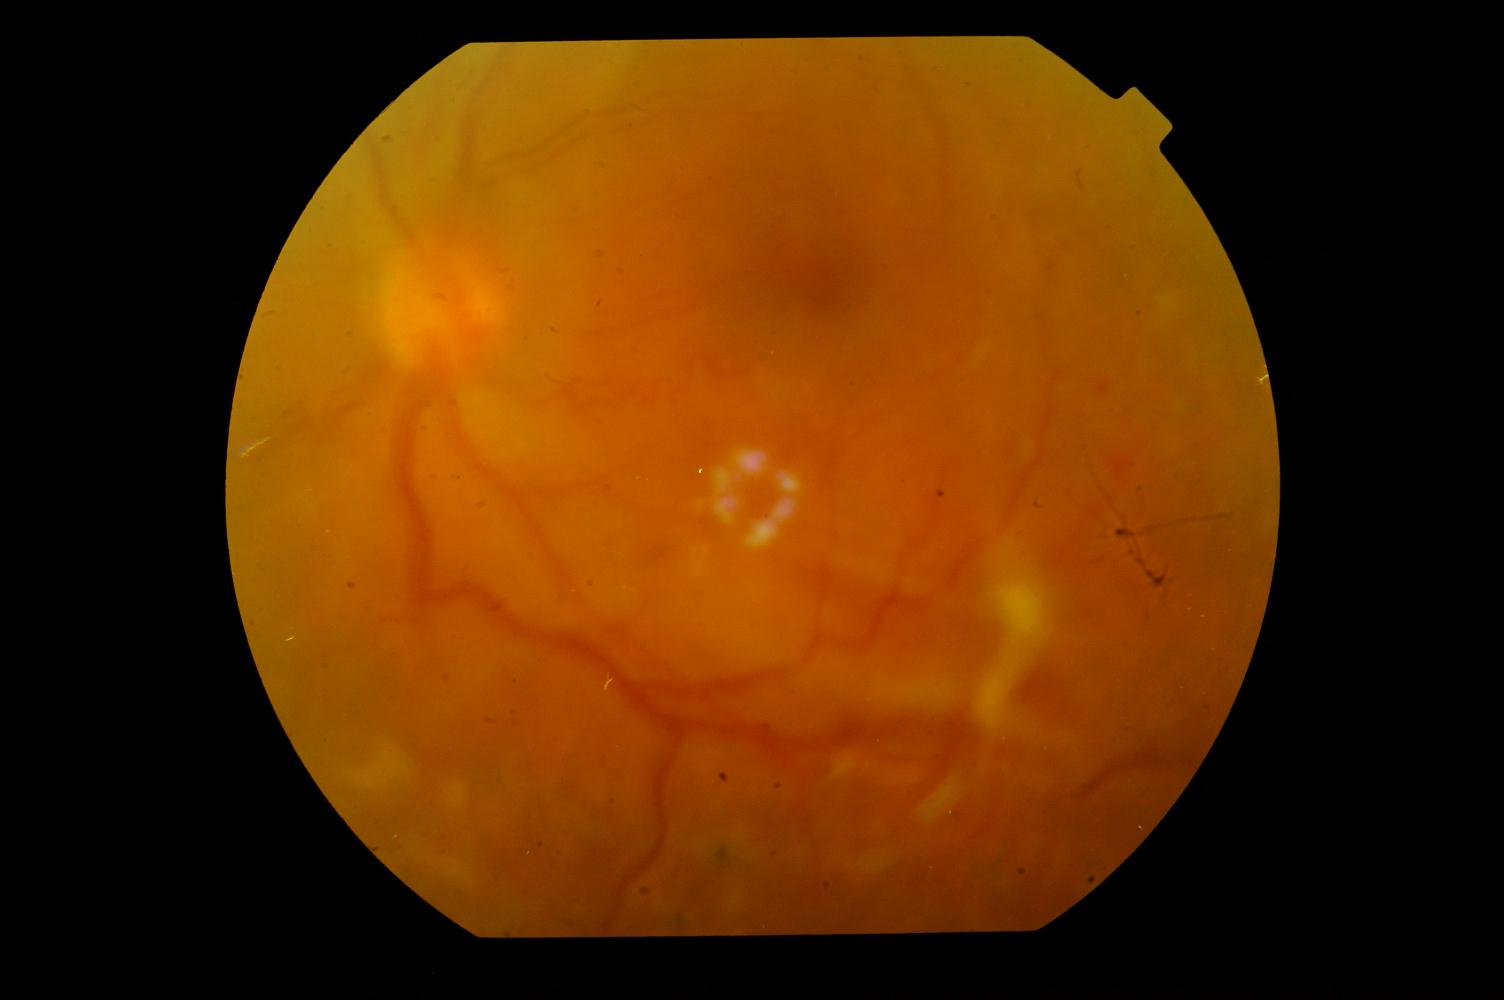
Findings consistent with diabetic retinopathy.